1659 x 2212 pixels; color fundus image.
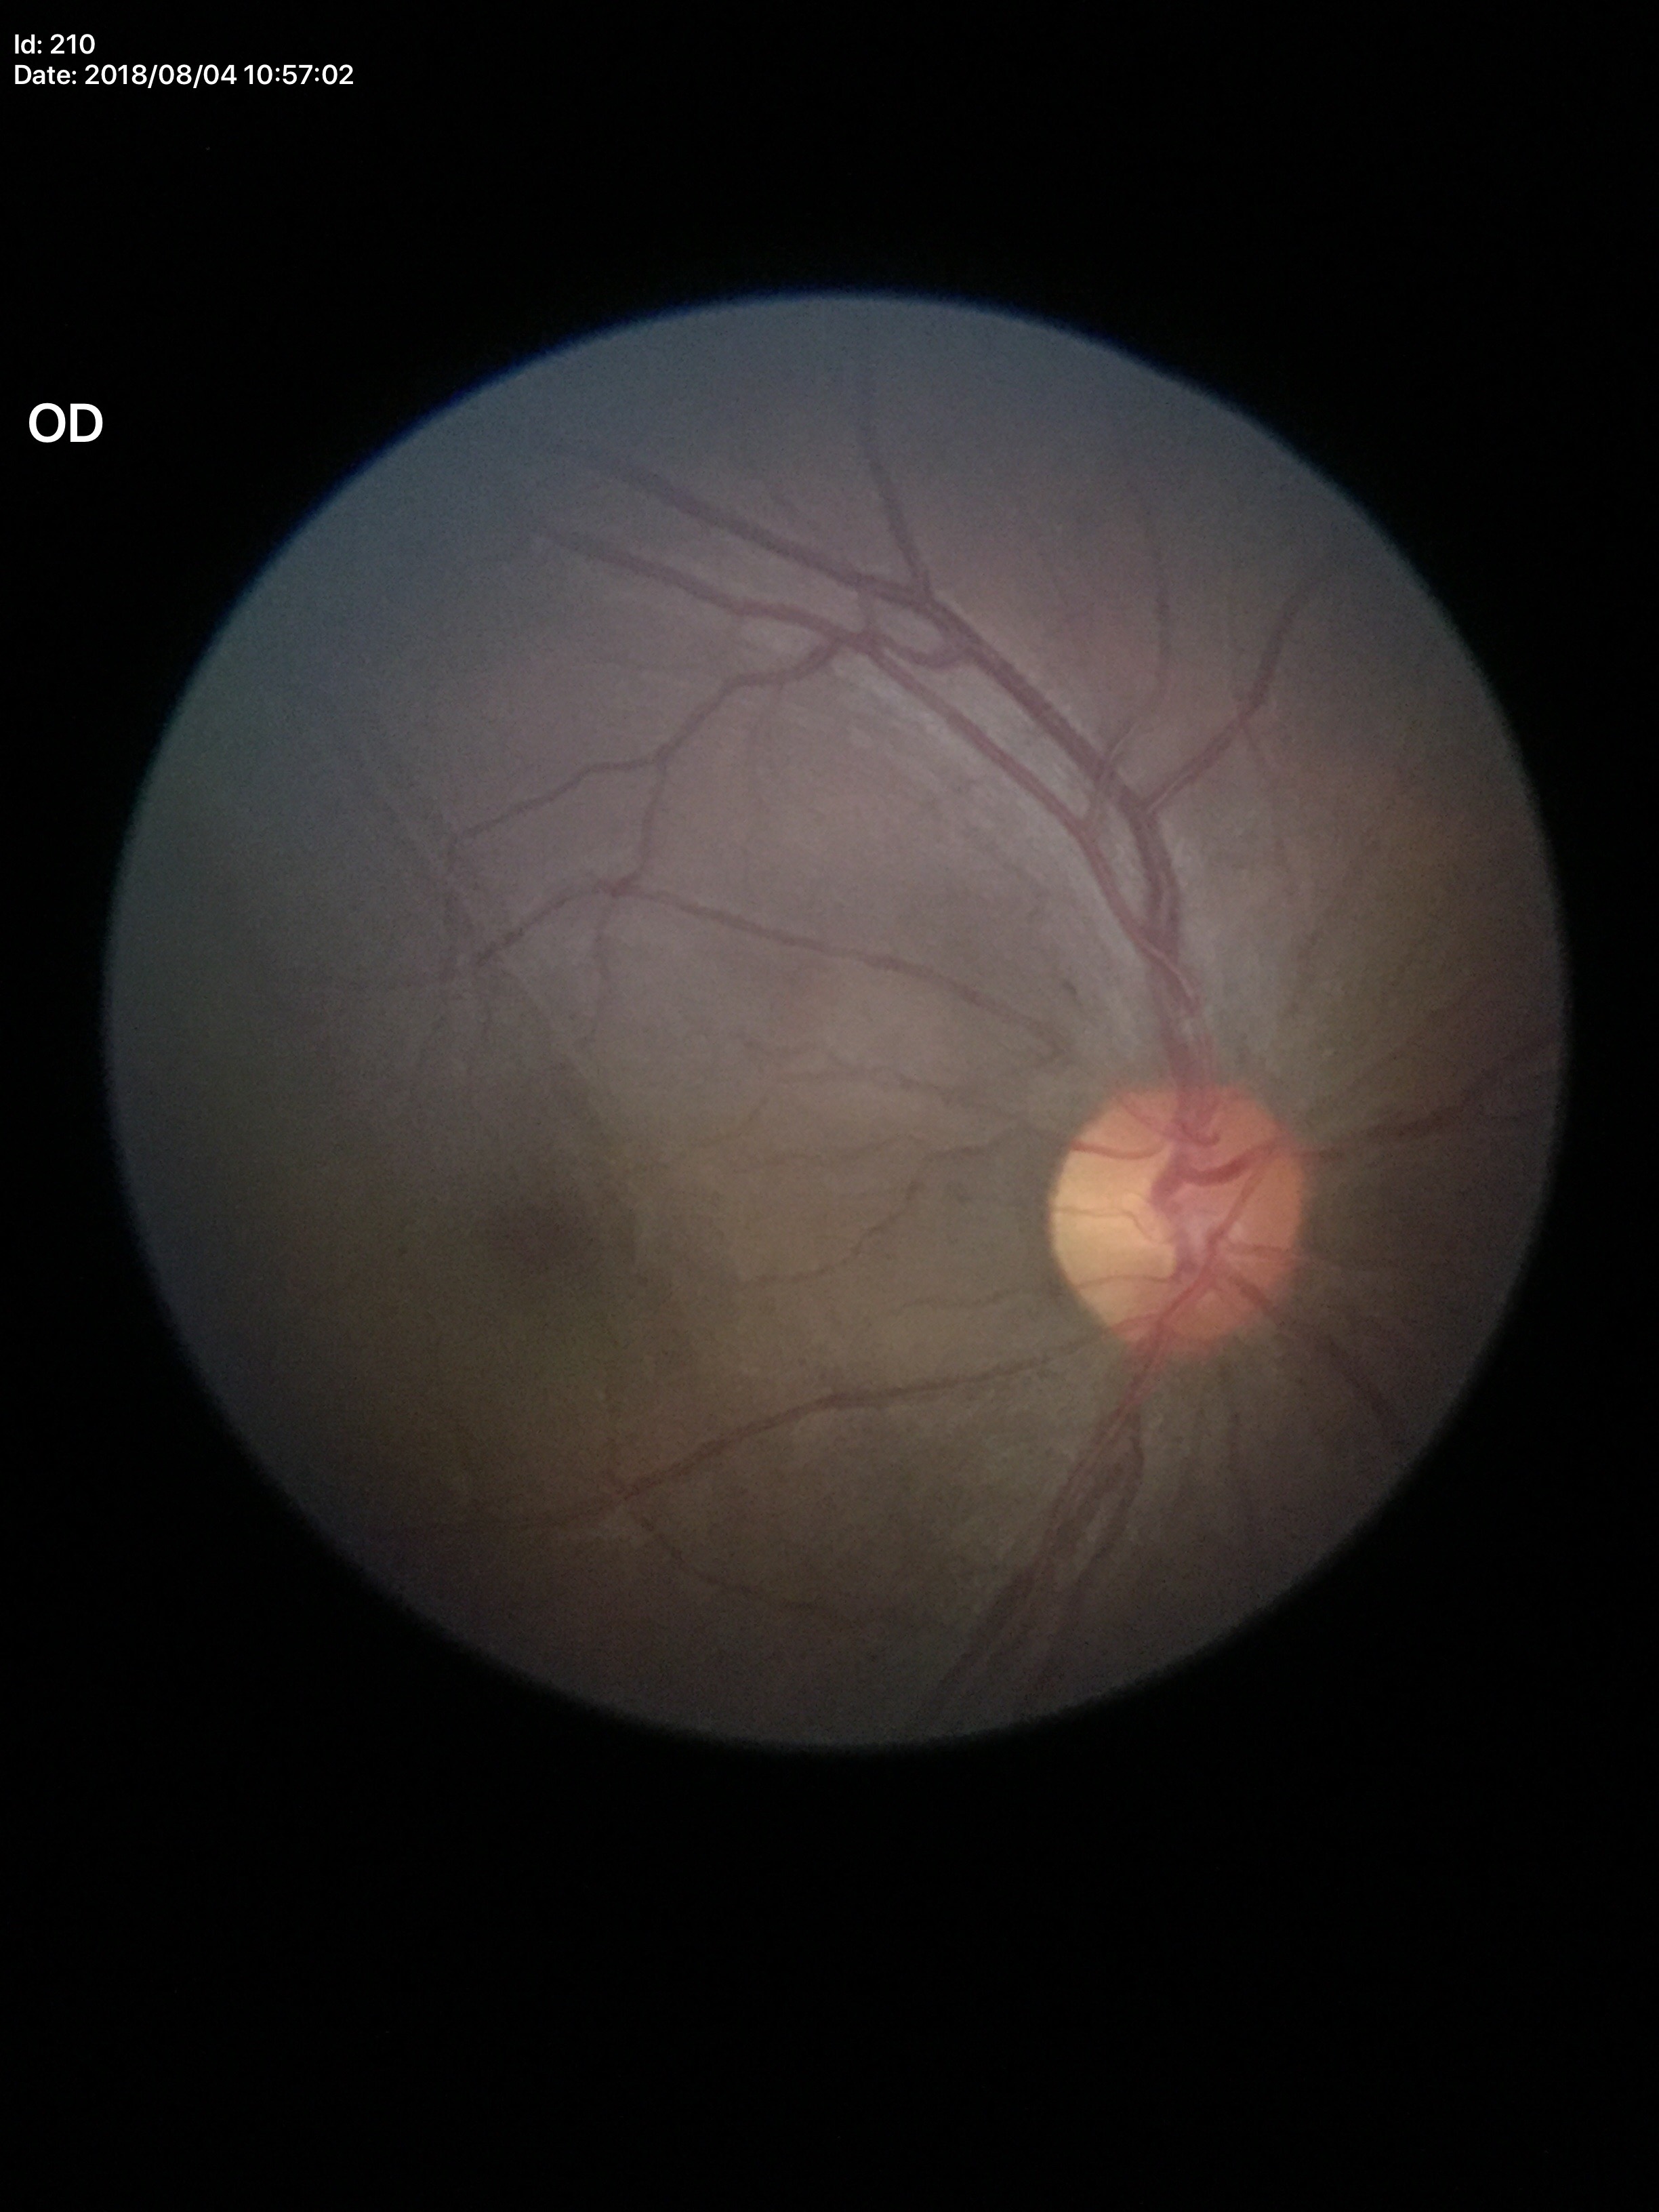 vertical CDR (VCDR) = 0.48
Glaucoma evaluation = negative